Ultra-widefield fundus mosaic
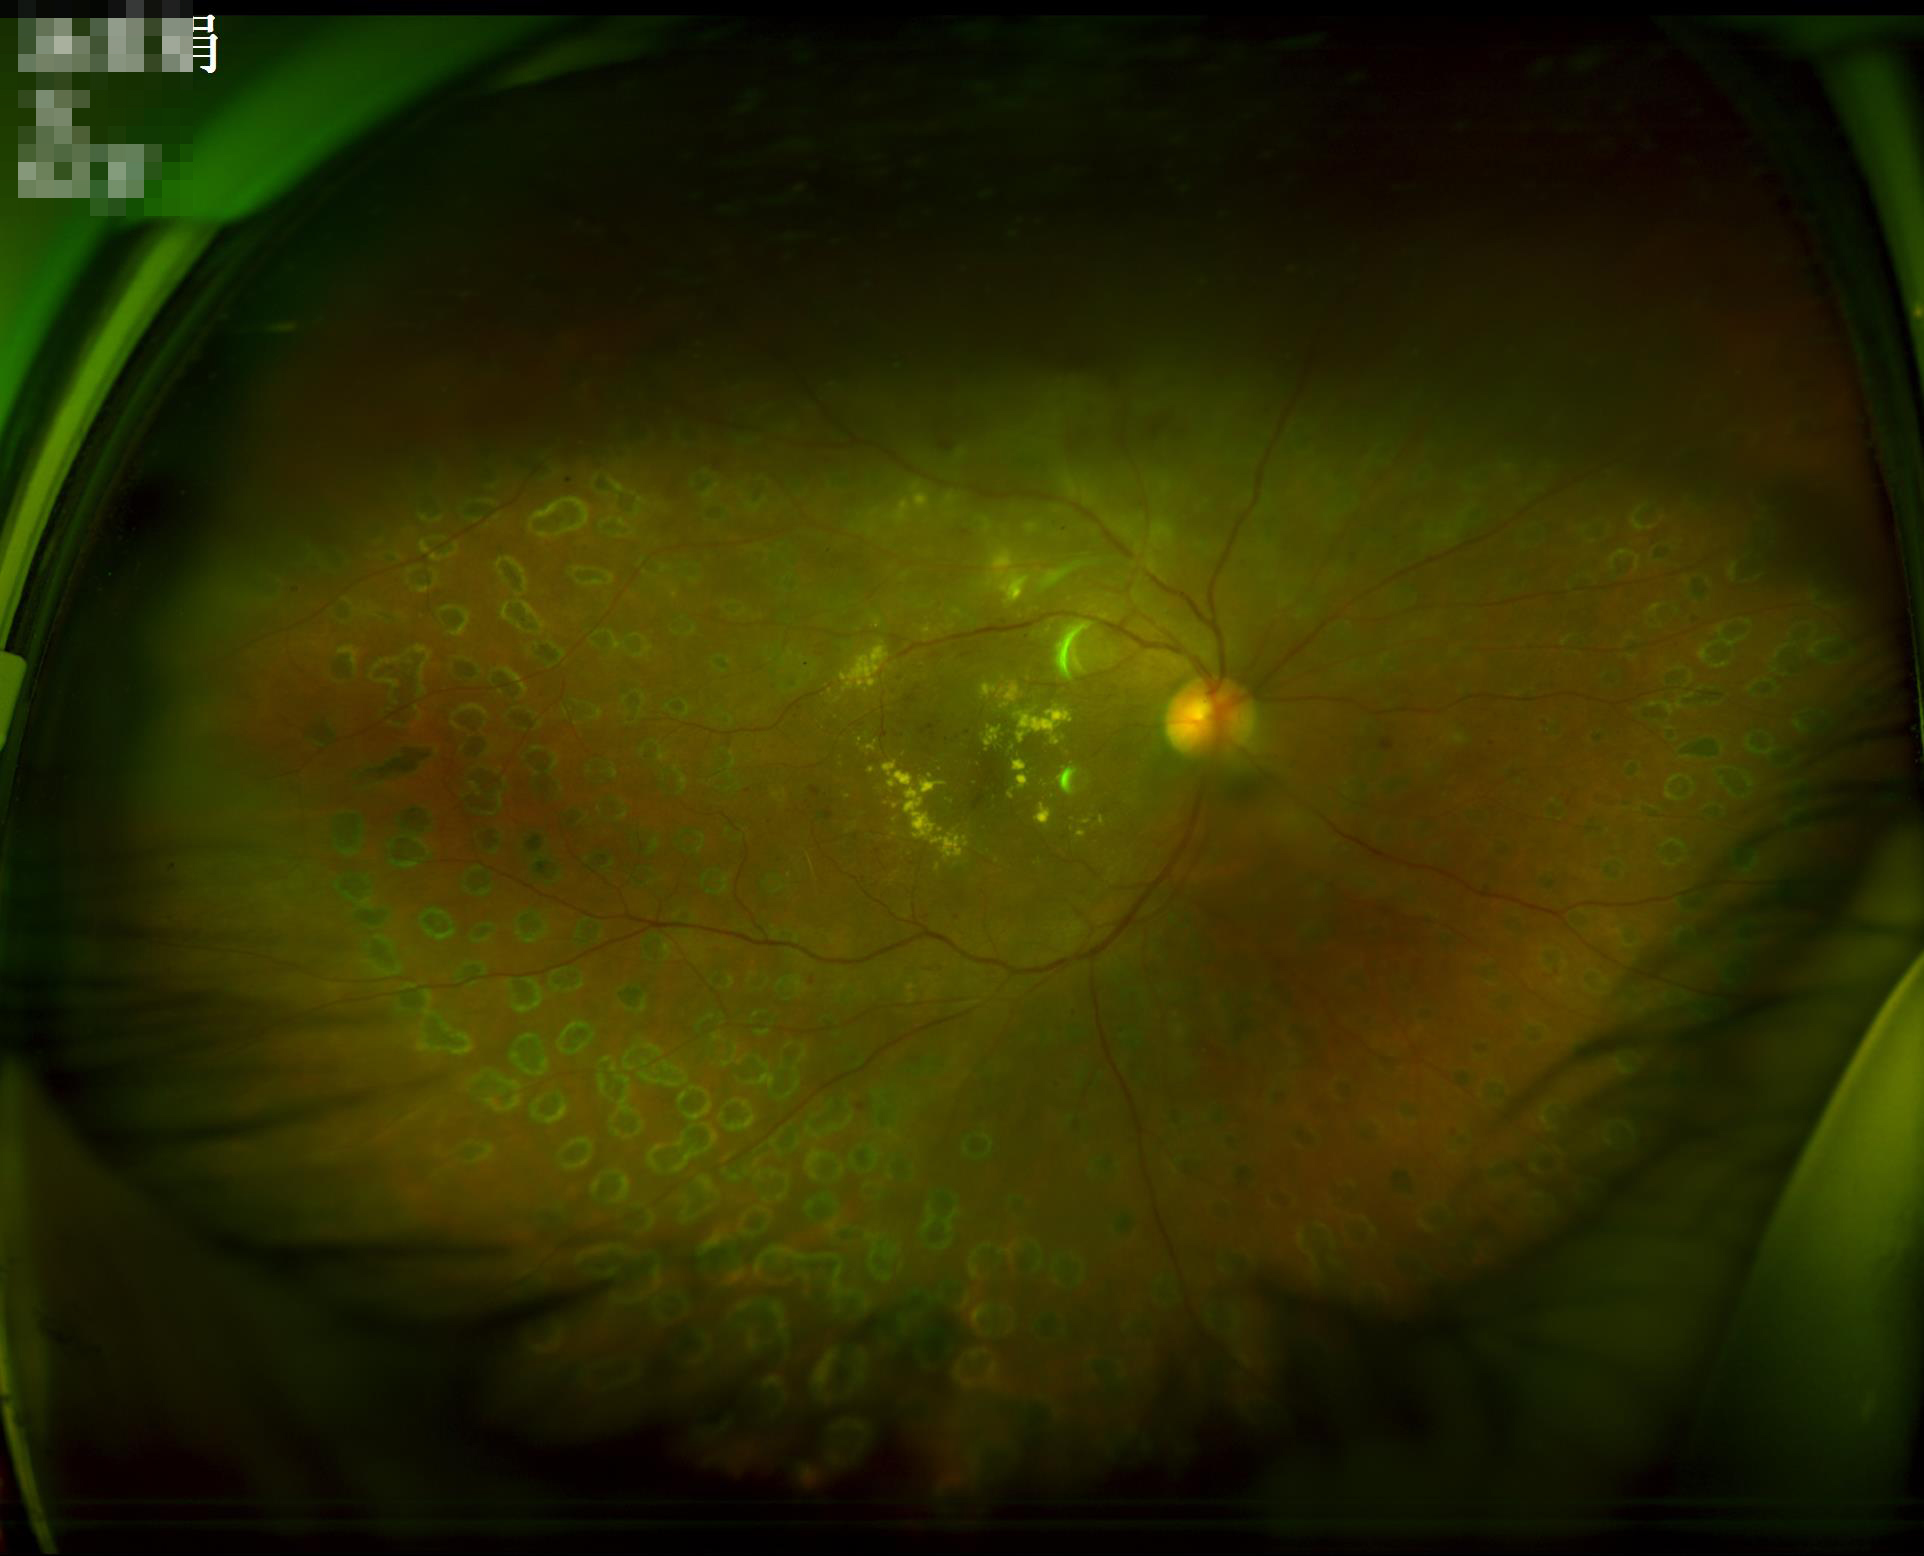

clarity: sharp
illumination: uneven
overall_quality: acceptable